Color fundus image. 848 by 848 pixels. NIDEK AFC-230 fundus camera.
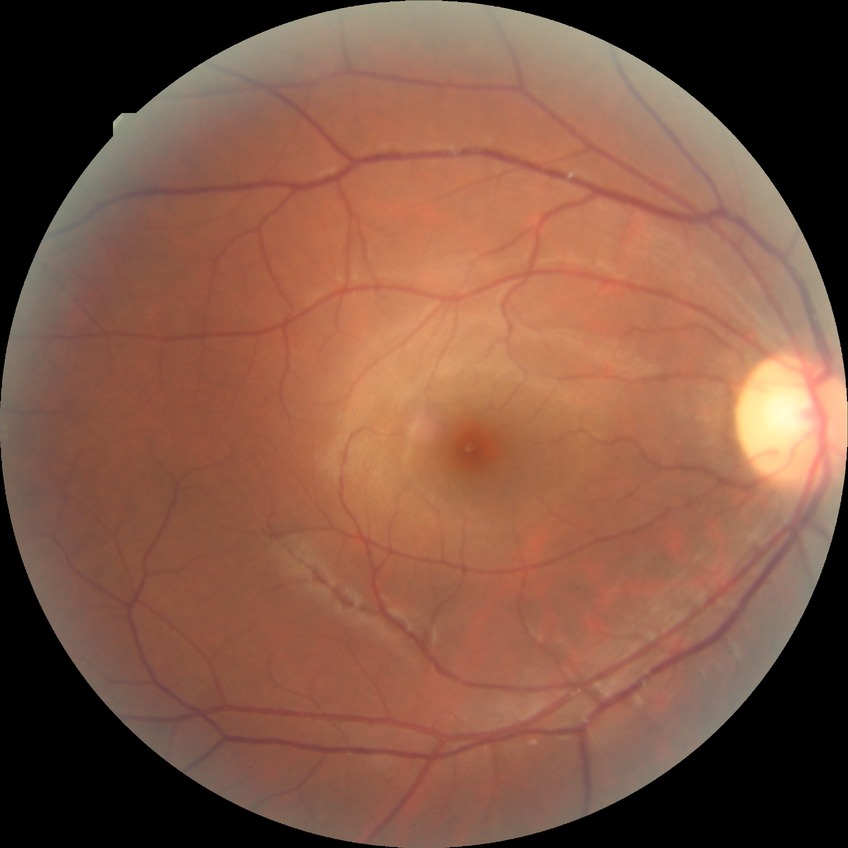

davis_grade: no diabetic retinopathy